45° FOV; image size 848x848; NIDEK AFC-230 fundus camera; no pharmacologic dilation; modified Davis grading — 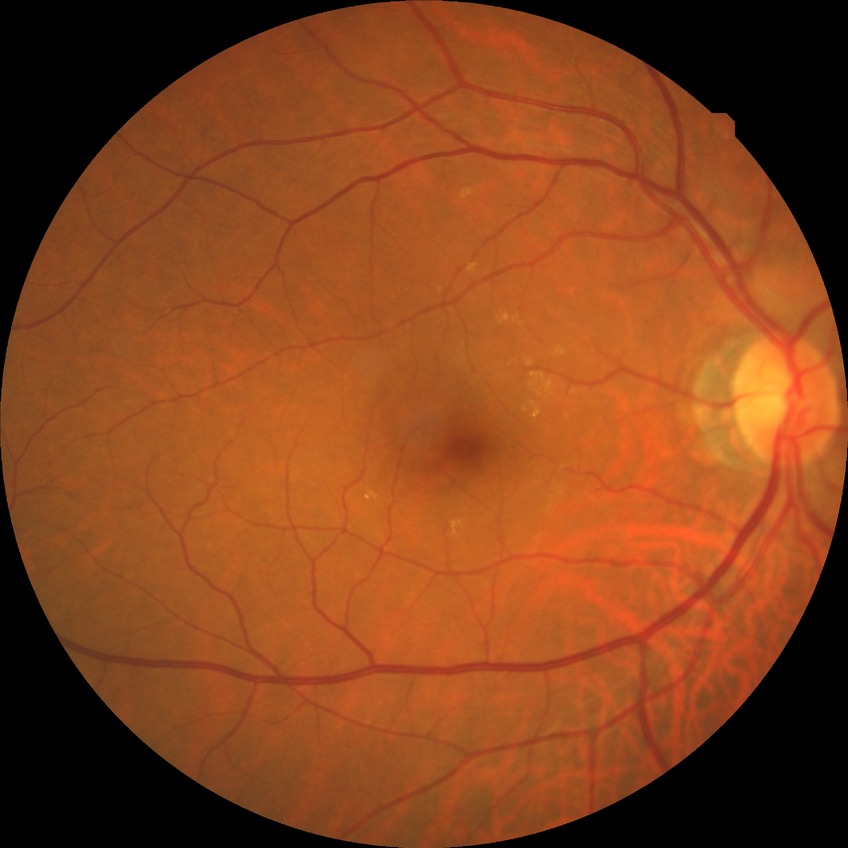

diabetic retinopathy severity=no diabetic retinopathy.